848x848, 45° FOV:
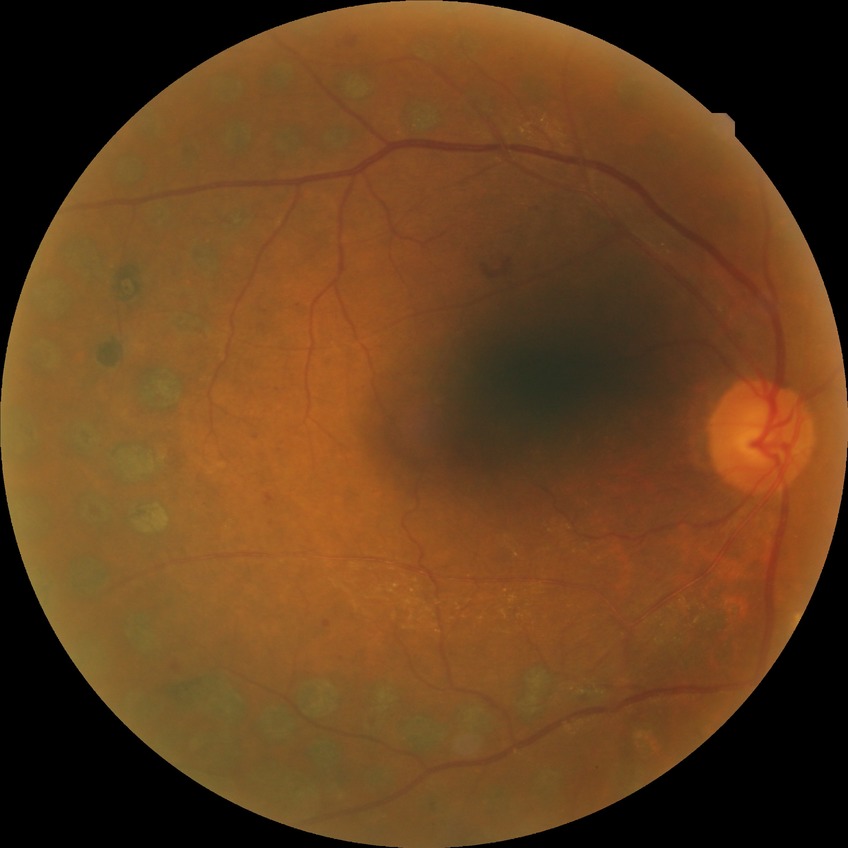

Retinopathy stage is proliferative diabetic retinopathy.